Image size 2102x1736, color fundus photograph: 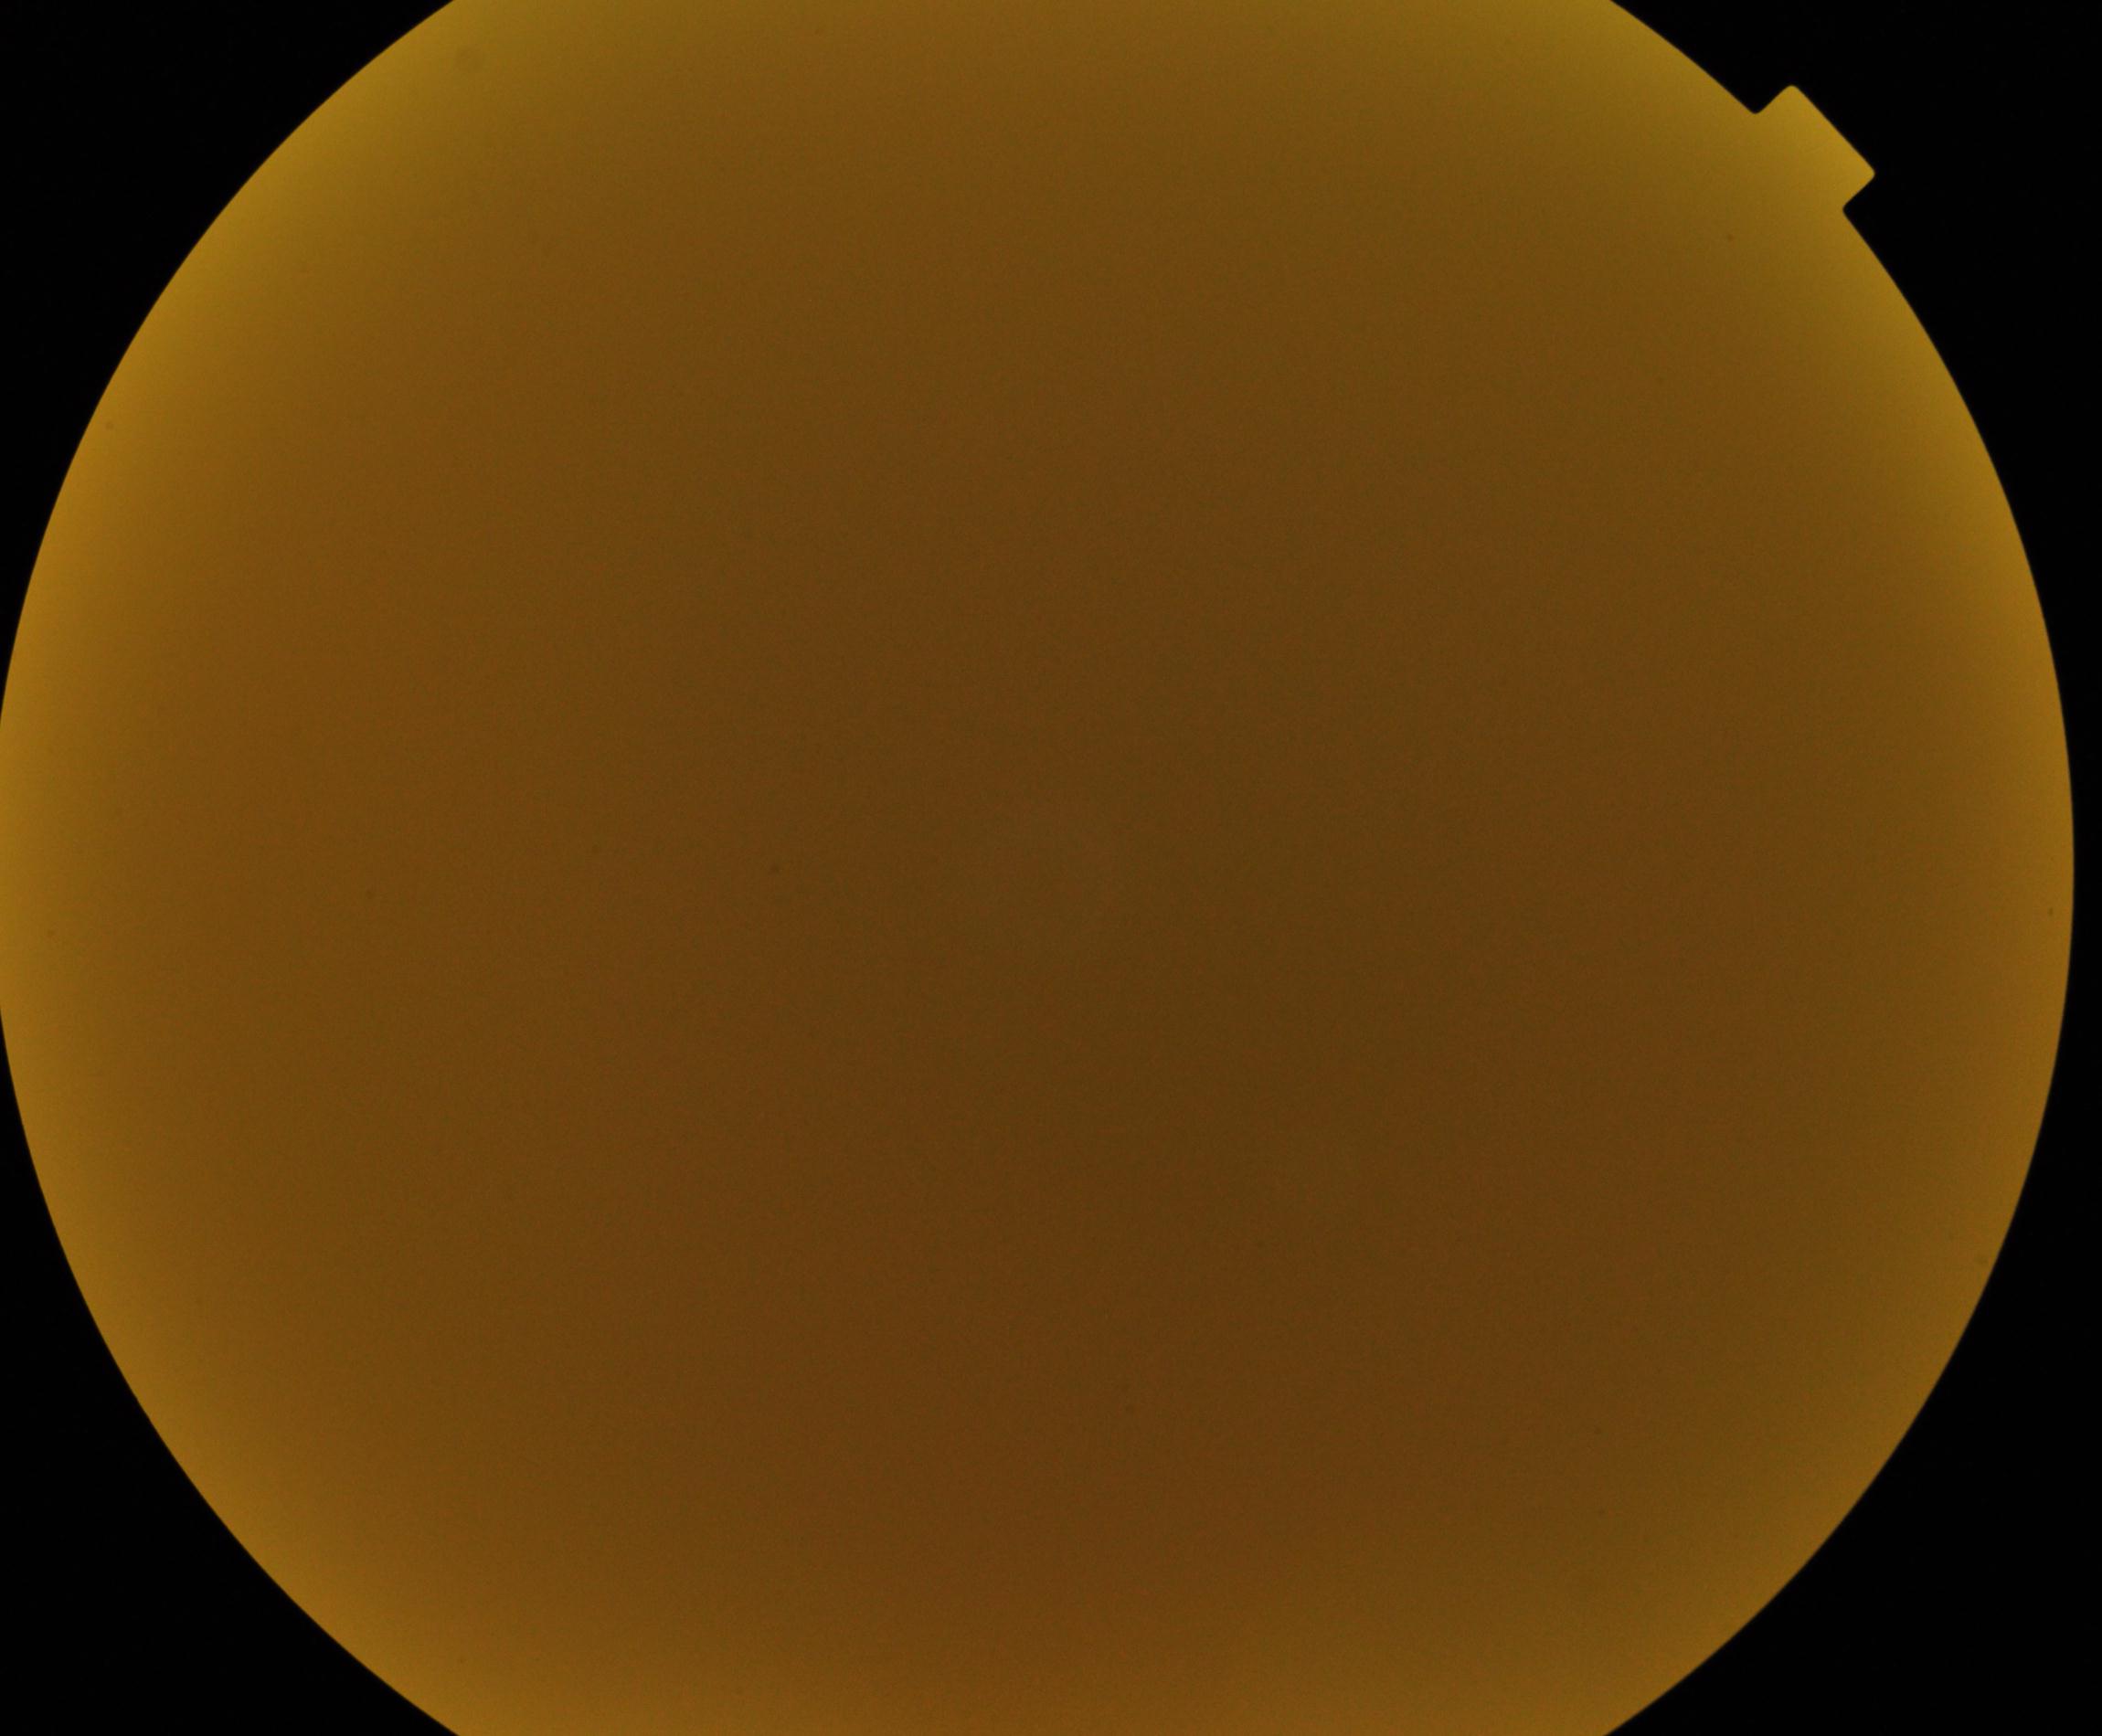
Significantly degraded image quality with obscured retinal detail. Proliferative diabetic retinopathy not identified in the visible portion.